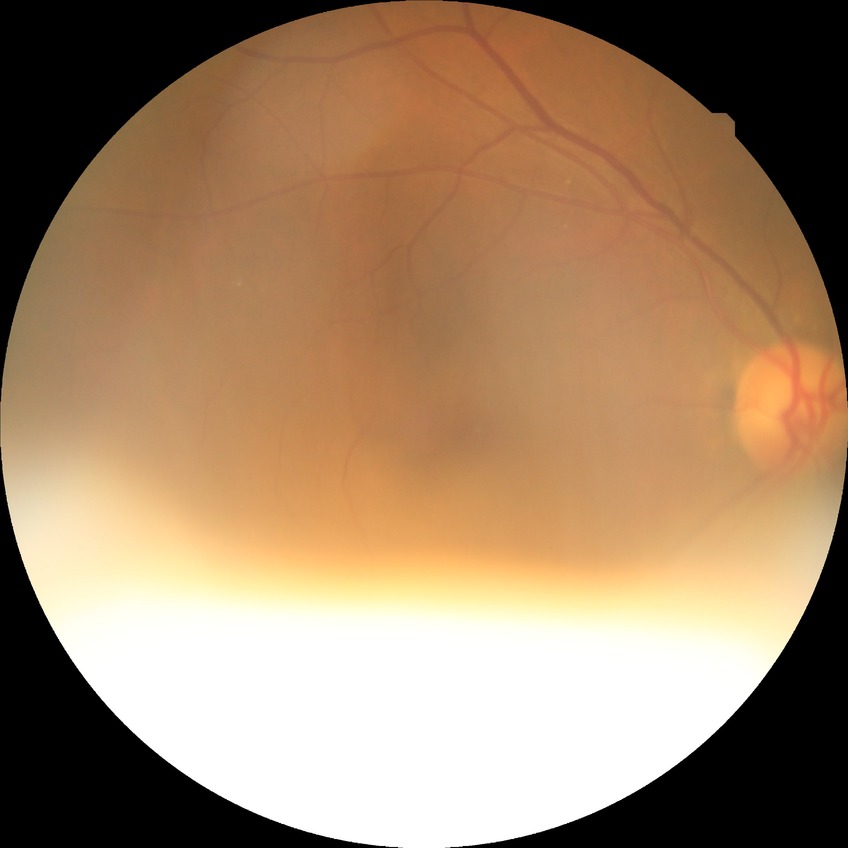

Diabetic retinopathy (DR): no diabetic retinopathy (NDR).